Nidek AFC-330, non-mydriatic:
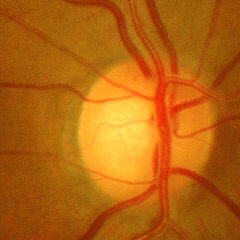

Showing advanced glaucoma.